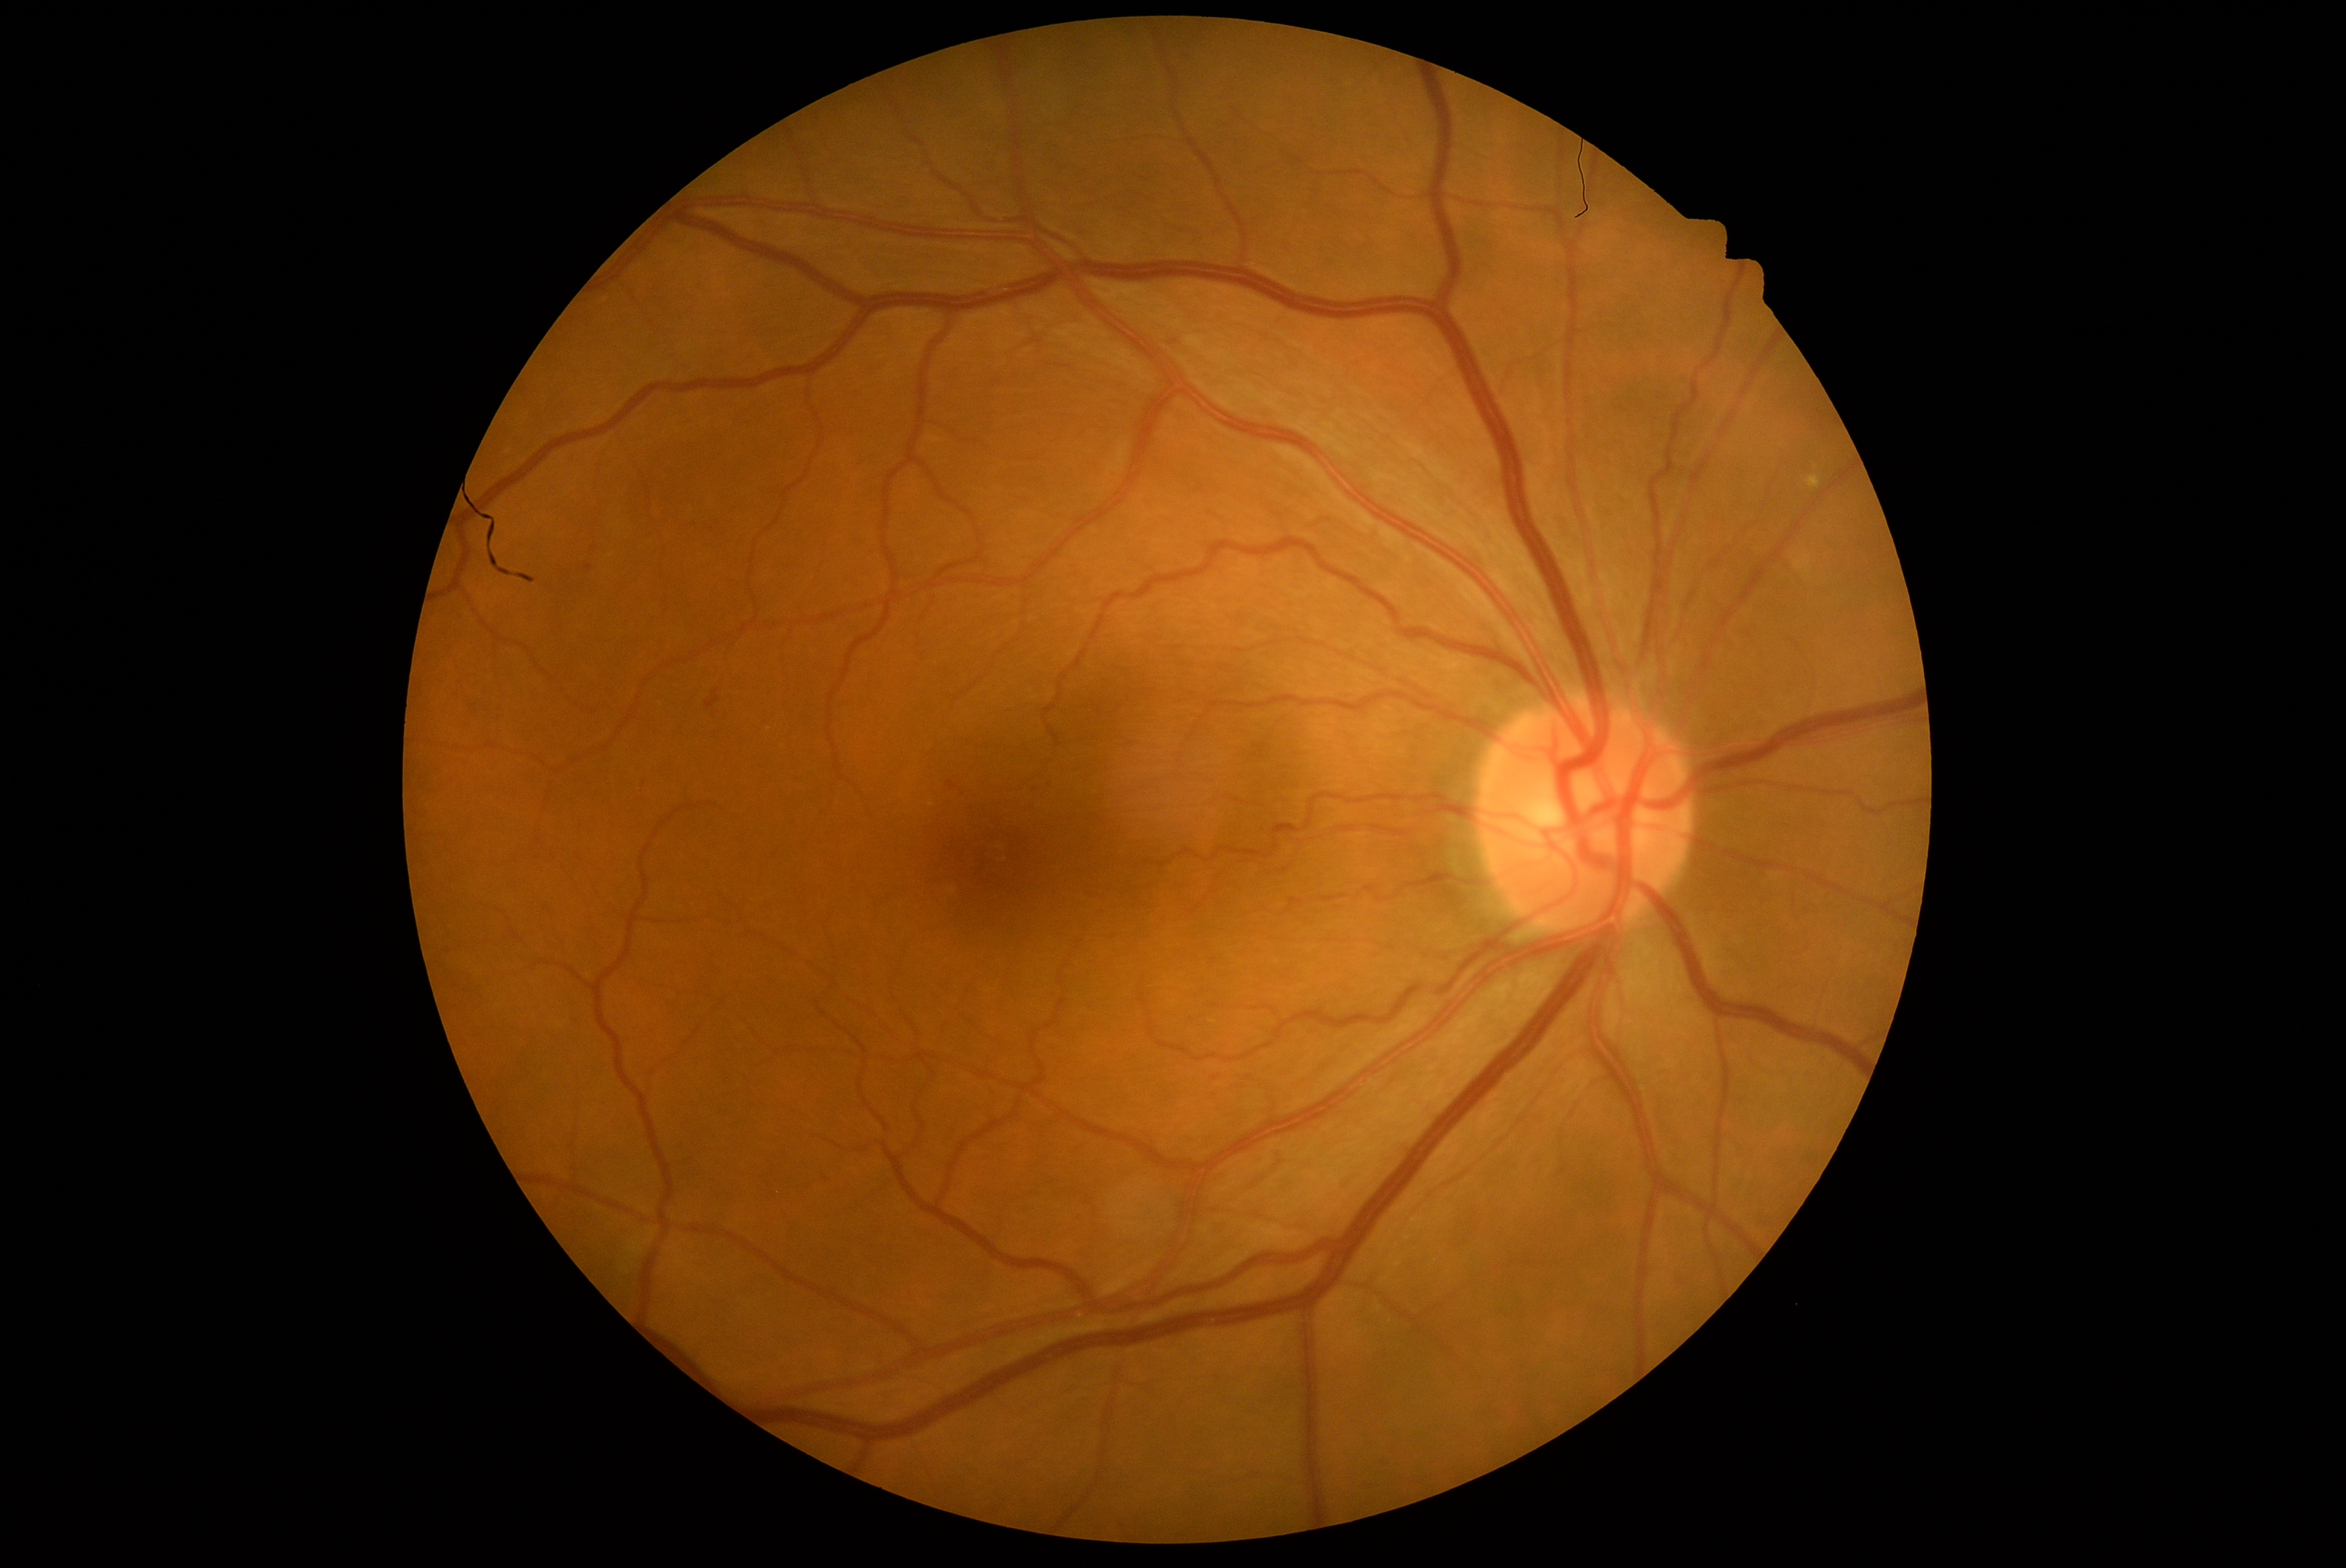 diabetic retinopathy (DR): moderate non-proliferative diabetic retinopathy (grade 2).